Color fundus image, 2048x1536: 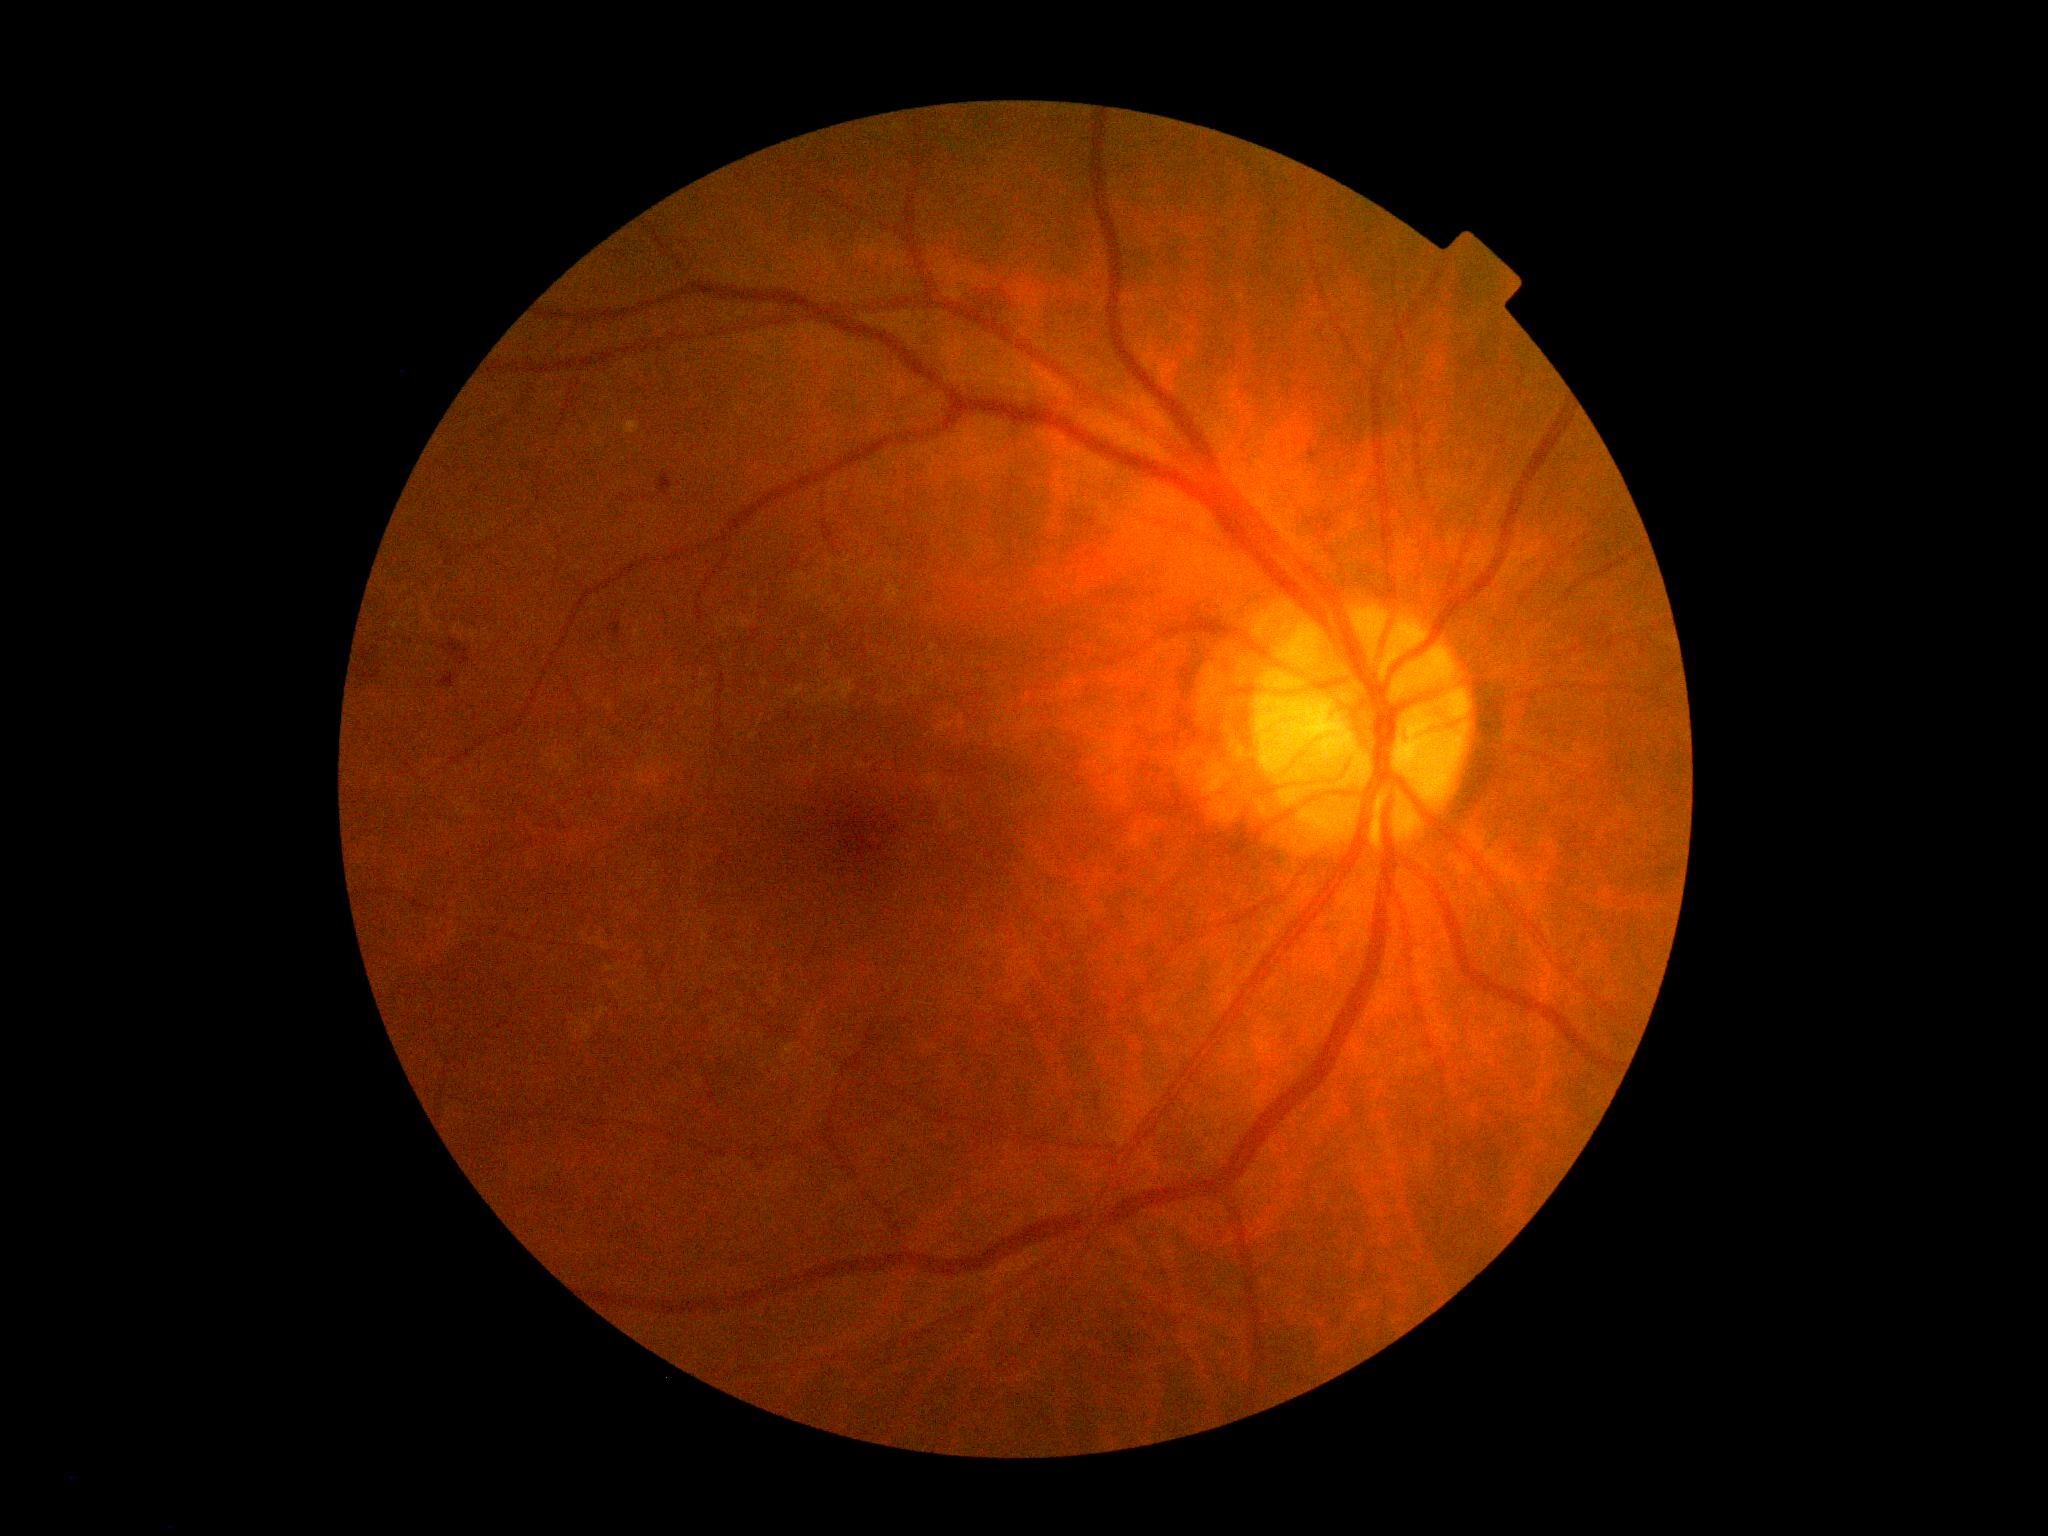

  dr_grade: 2 (moderate NPDR)